Diabetic retinopathy graded by the modified Davis classification:
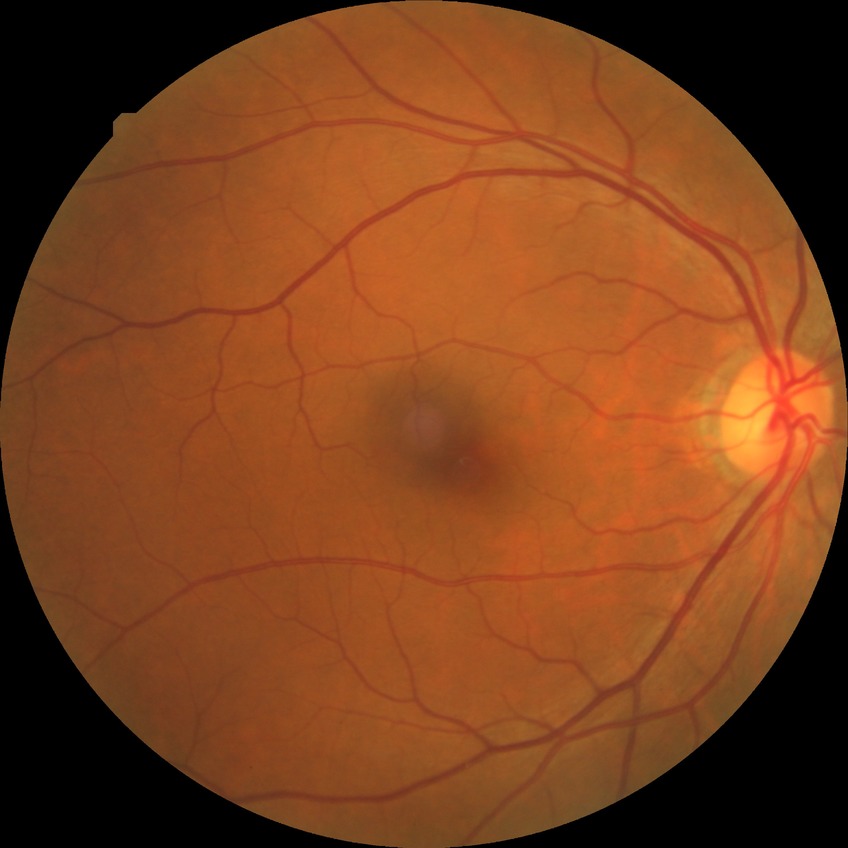 Diabetic retinopathy grade: no diabetic retinopathy.